45 degree fundus photograph, without pupil dilation
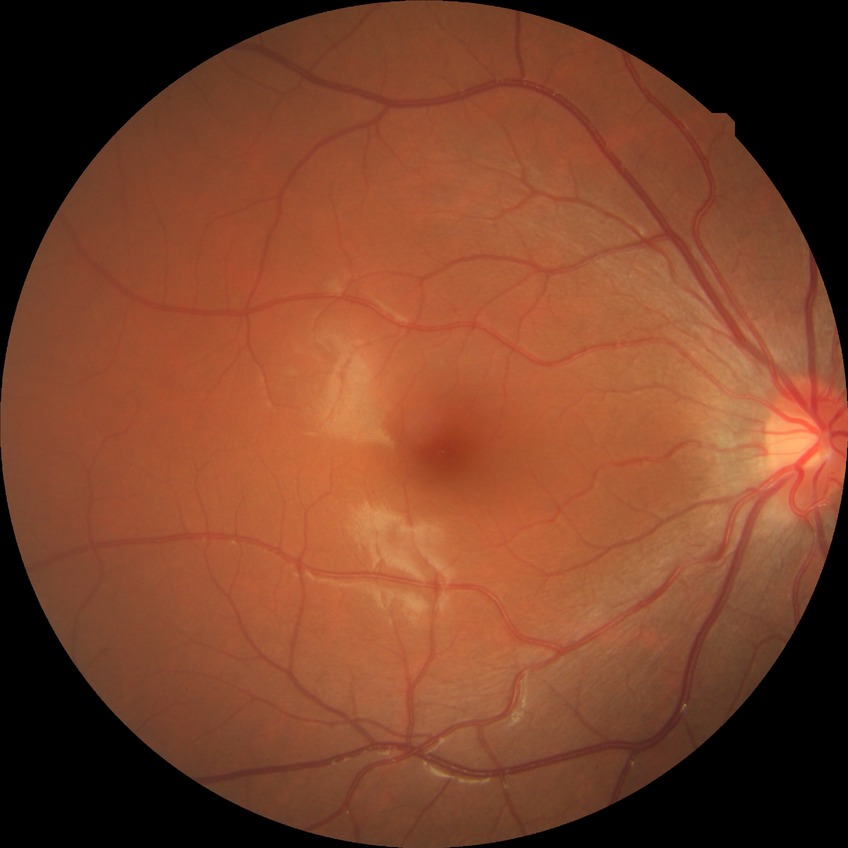 Disease class: non-proliferative diabetic retinopathy. Davis grading is simple diabetic retinopathy.